Fundus photo, 45° FOV, image size 2368x1568.
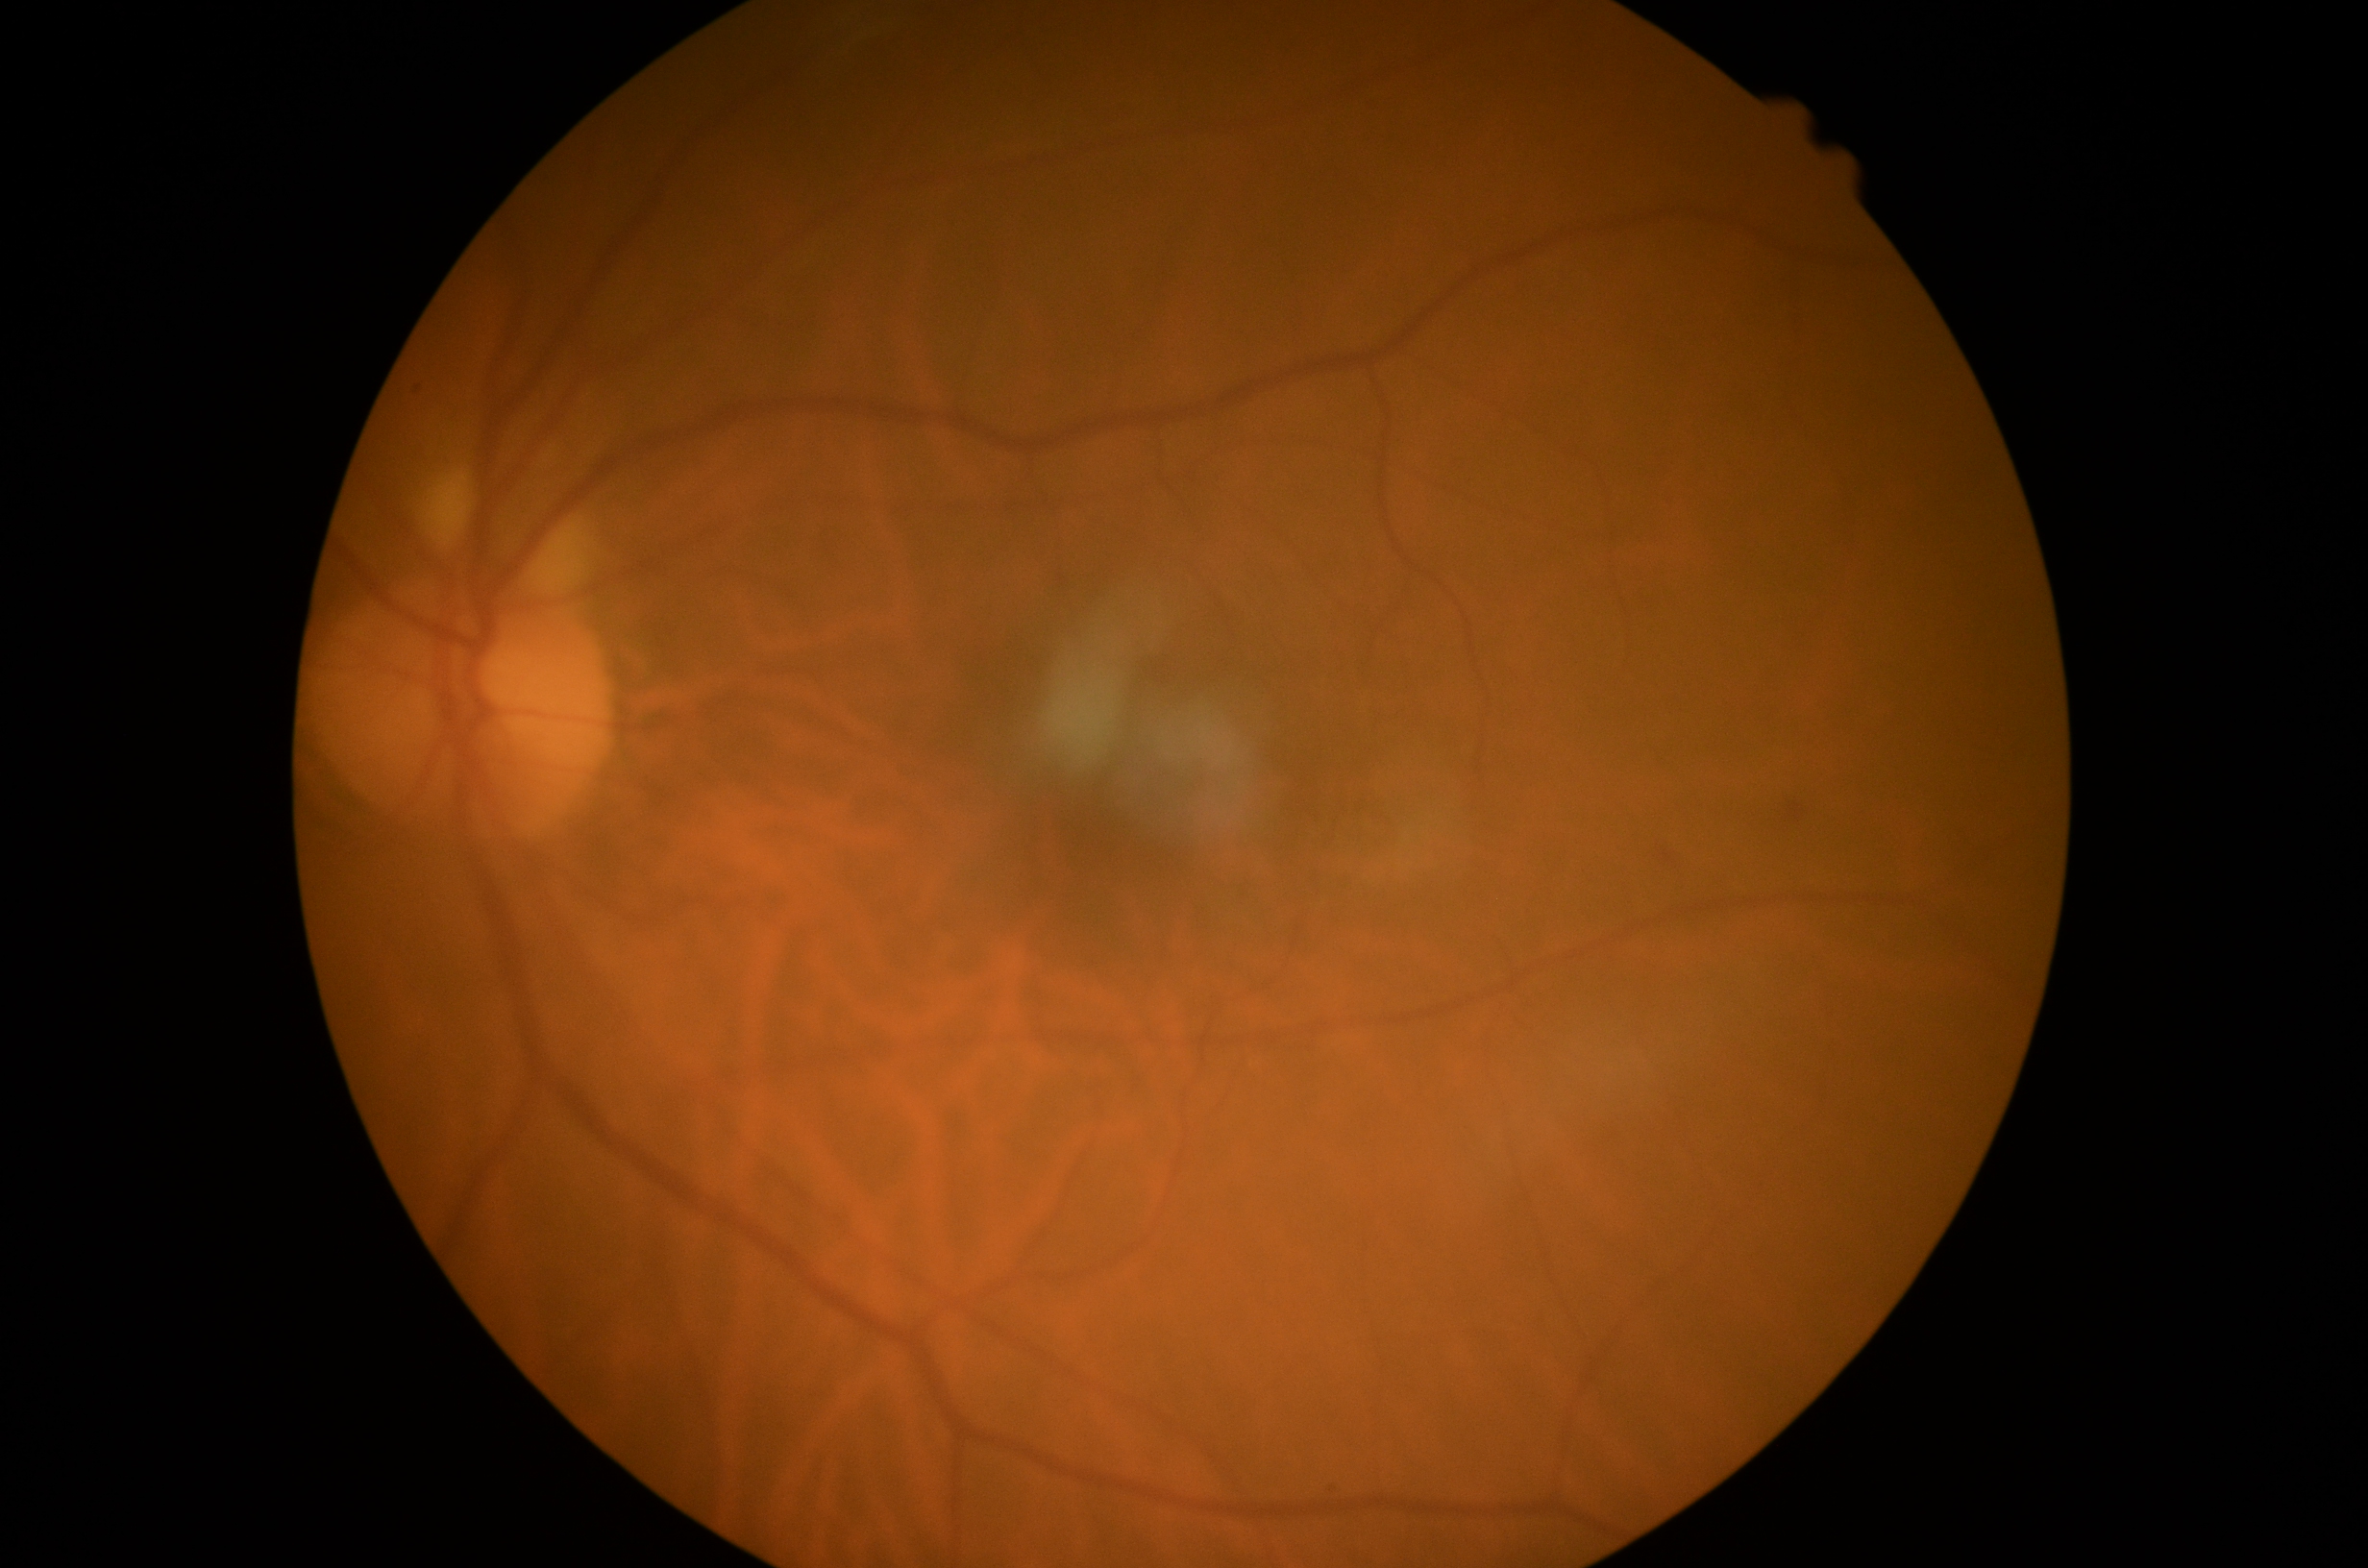 Retinopathy: moderate NPDR (grade 2).